1659 x 2212 pixels:
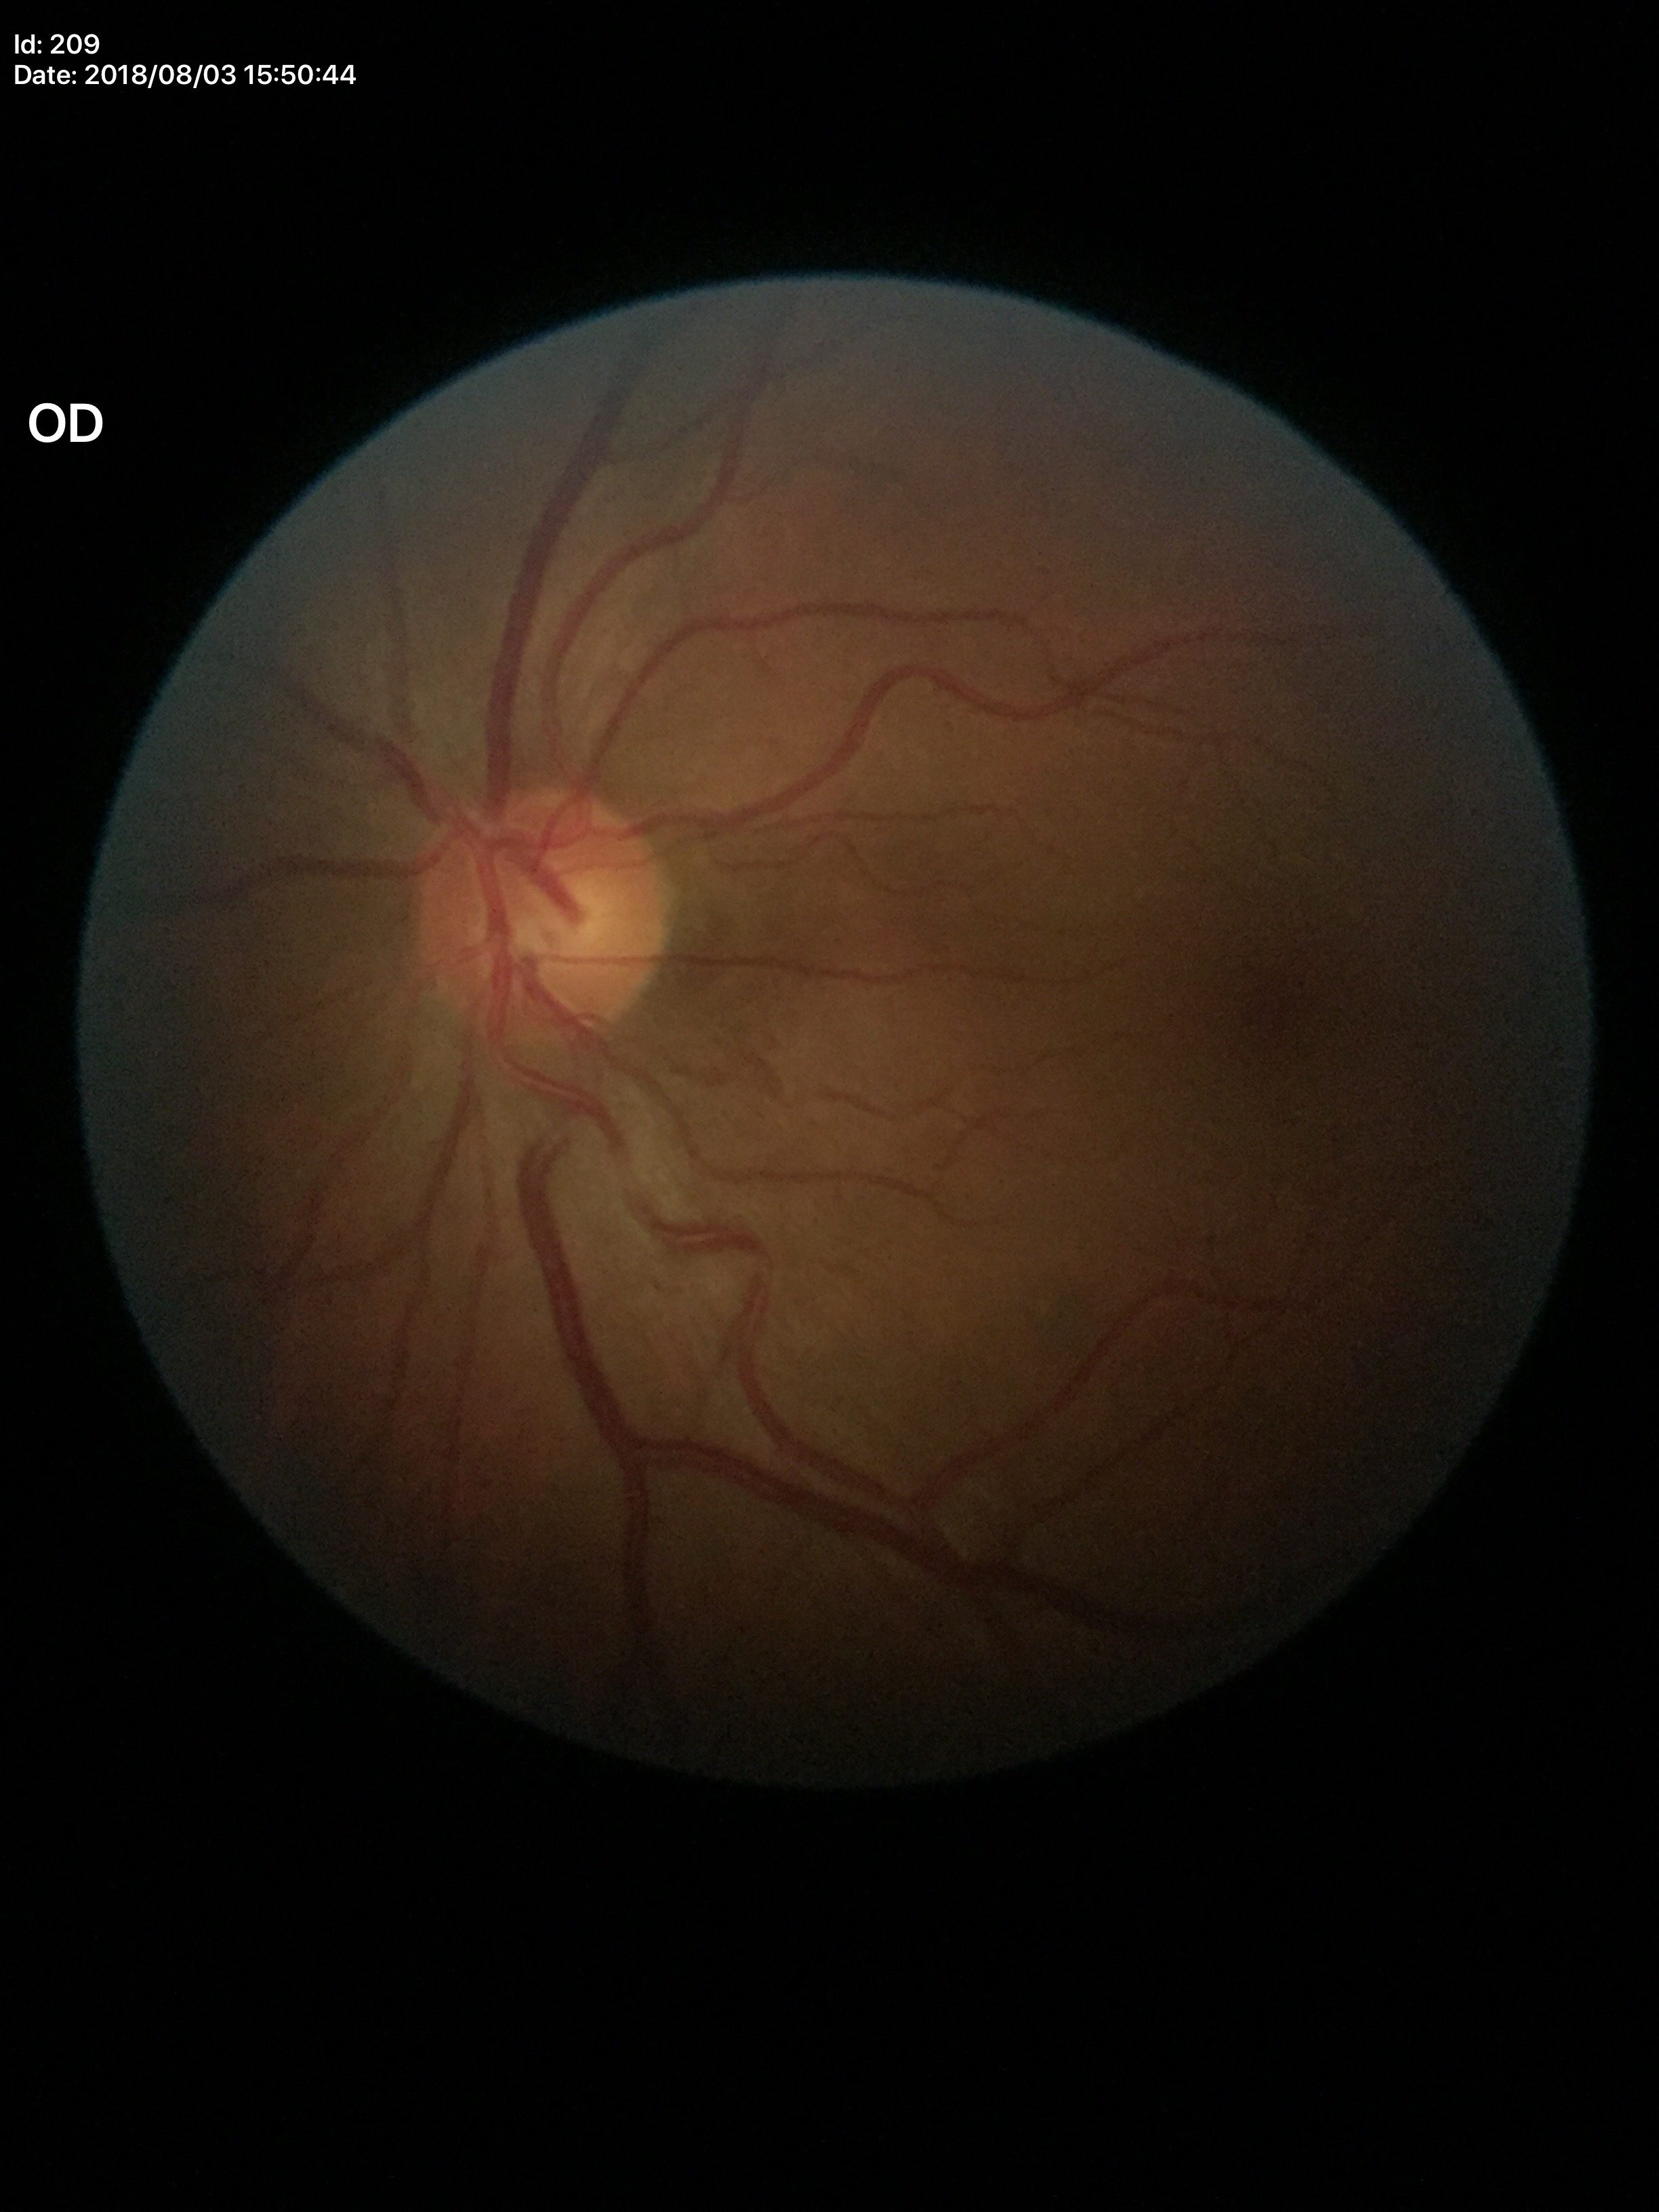

Findings:
• Glaucoma decision — not suspect (unanimous normal call)
• vertical CDR — 0.46